Color fundus photograph · 45° FOV — 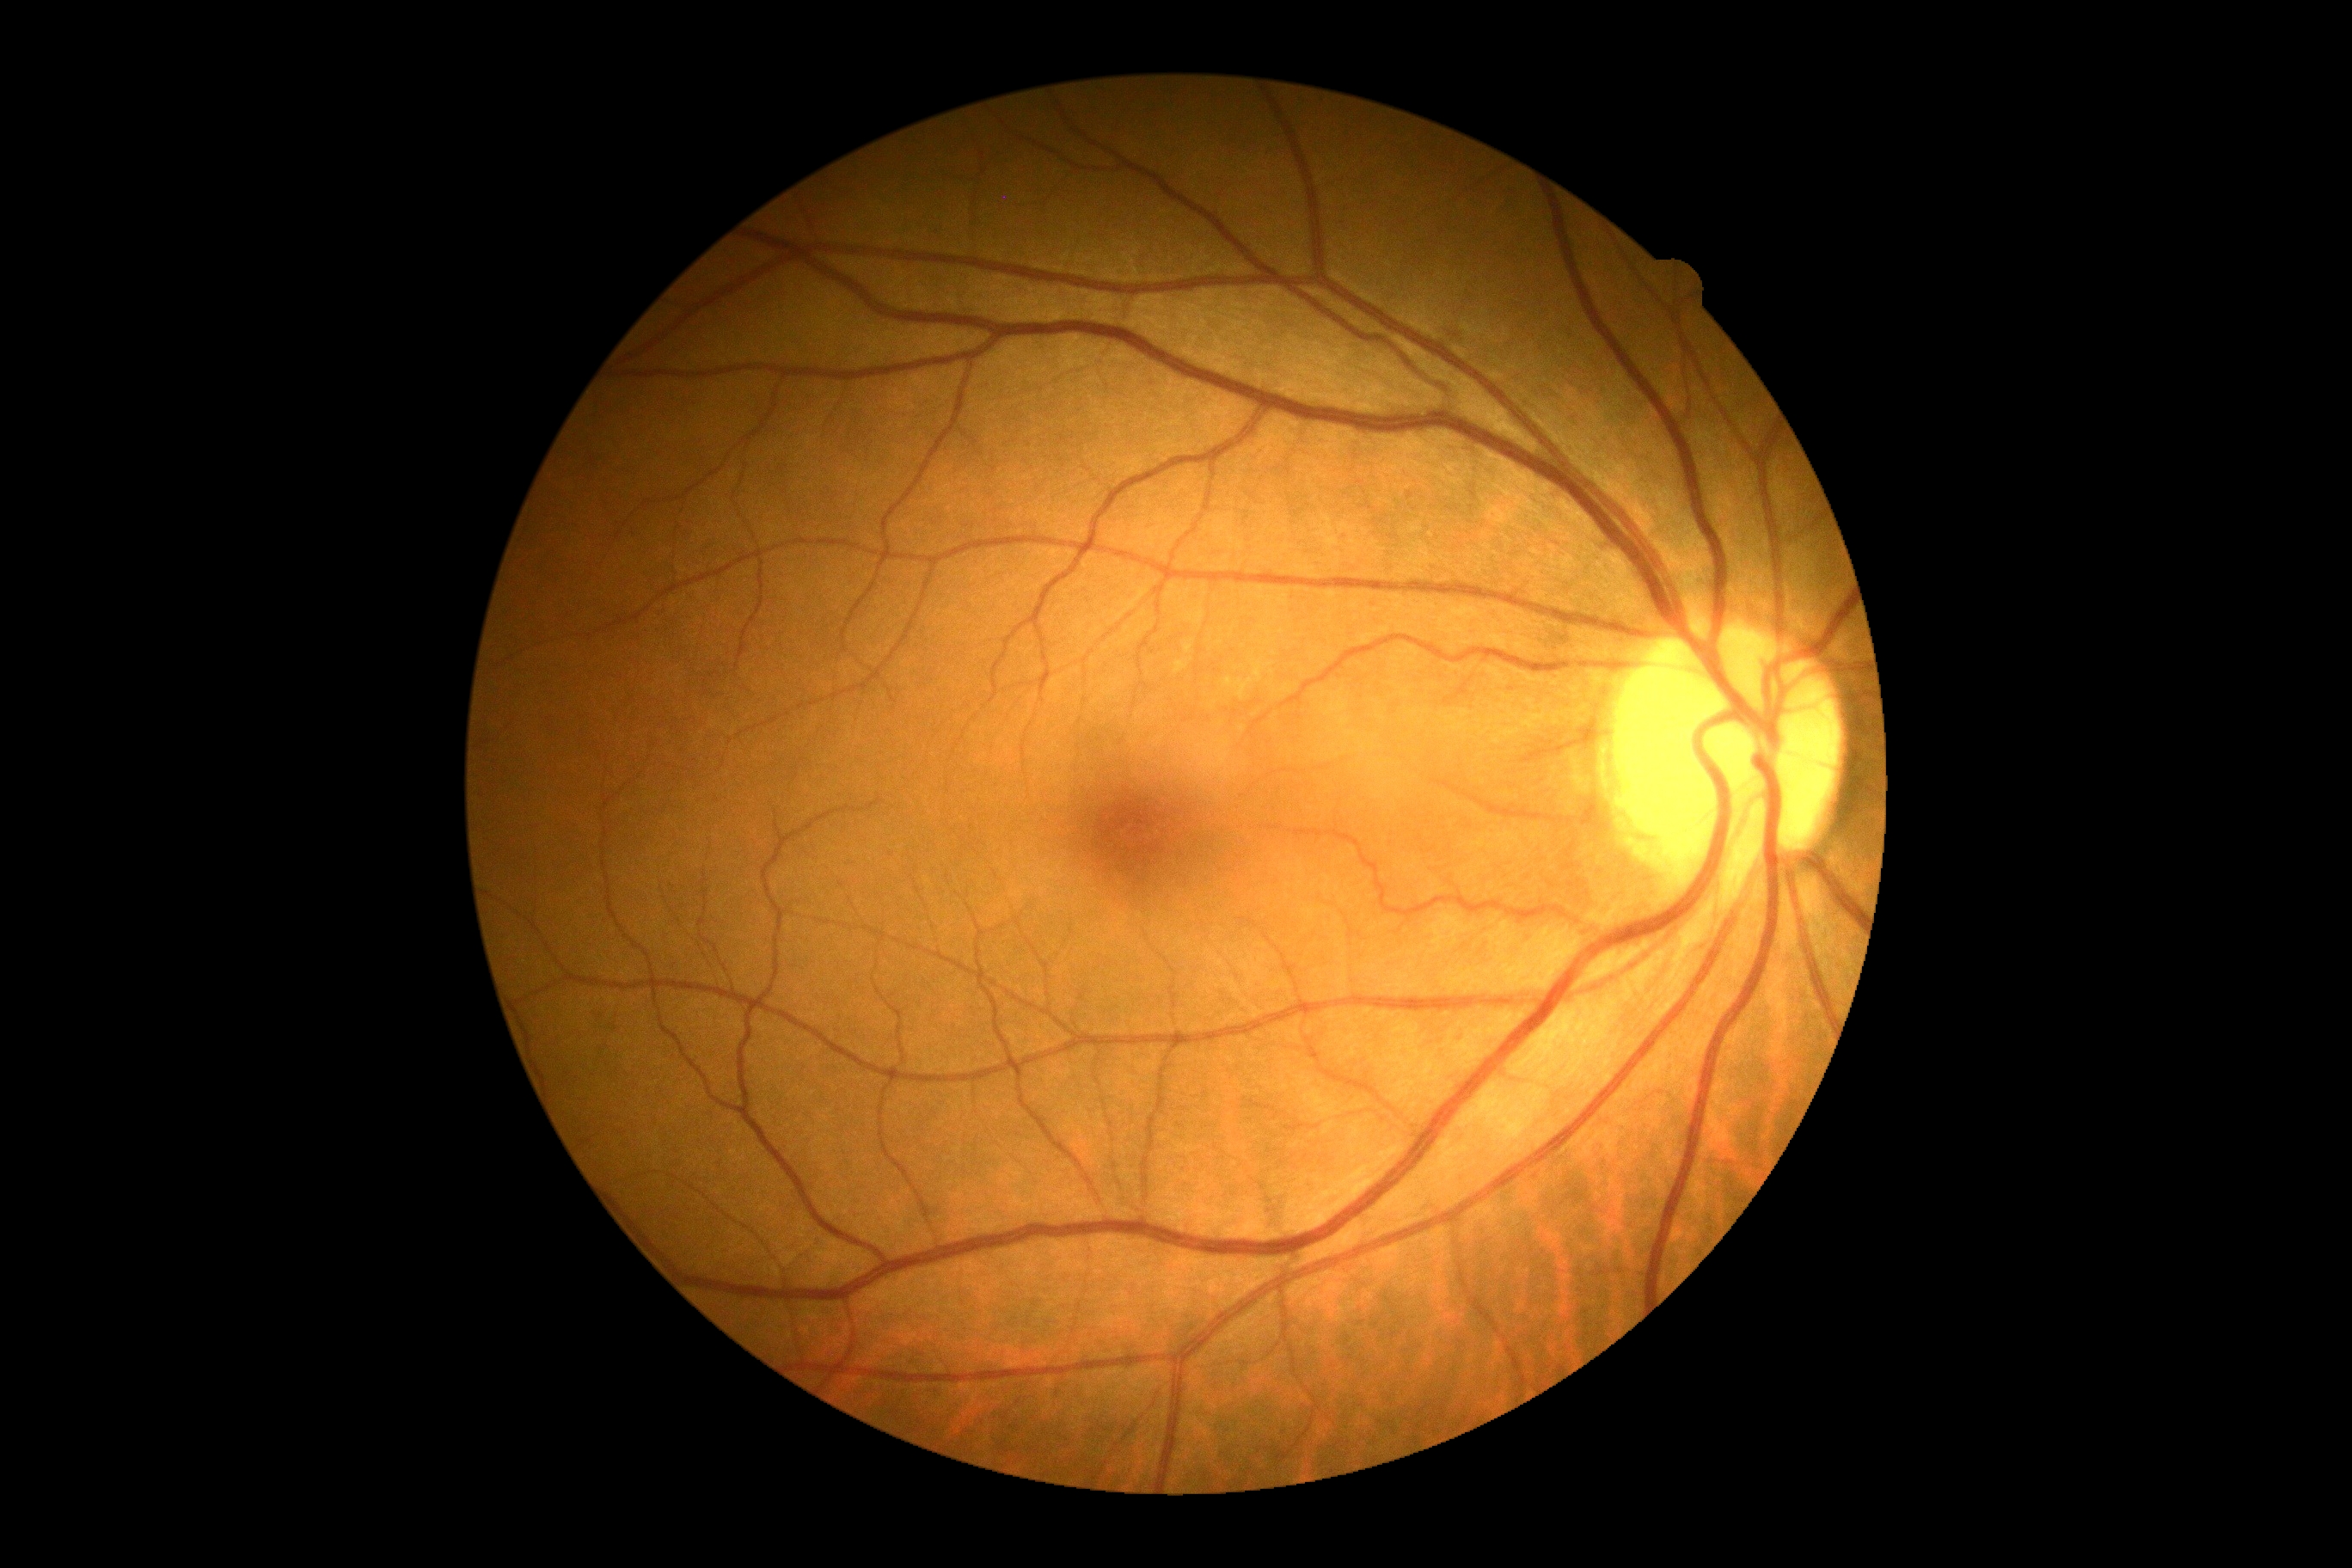
Diabetic retinopathy (DR): 0.